Image size 640x480; wide-field contact fundus photograph of an infant.
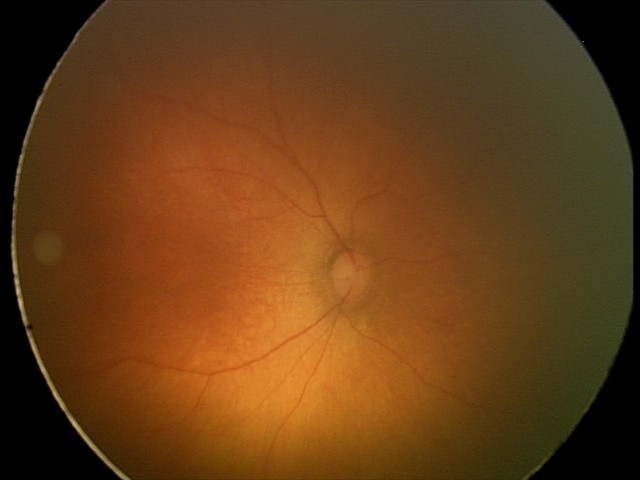

Screening diagnosis: physiological finding.